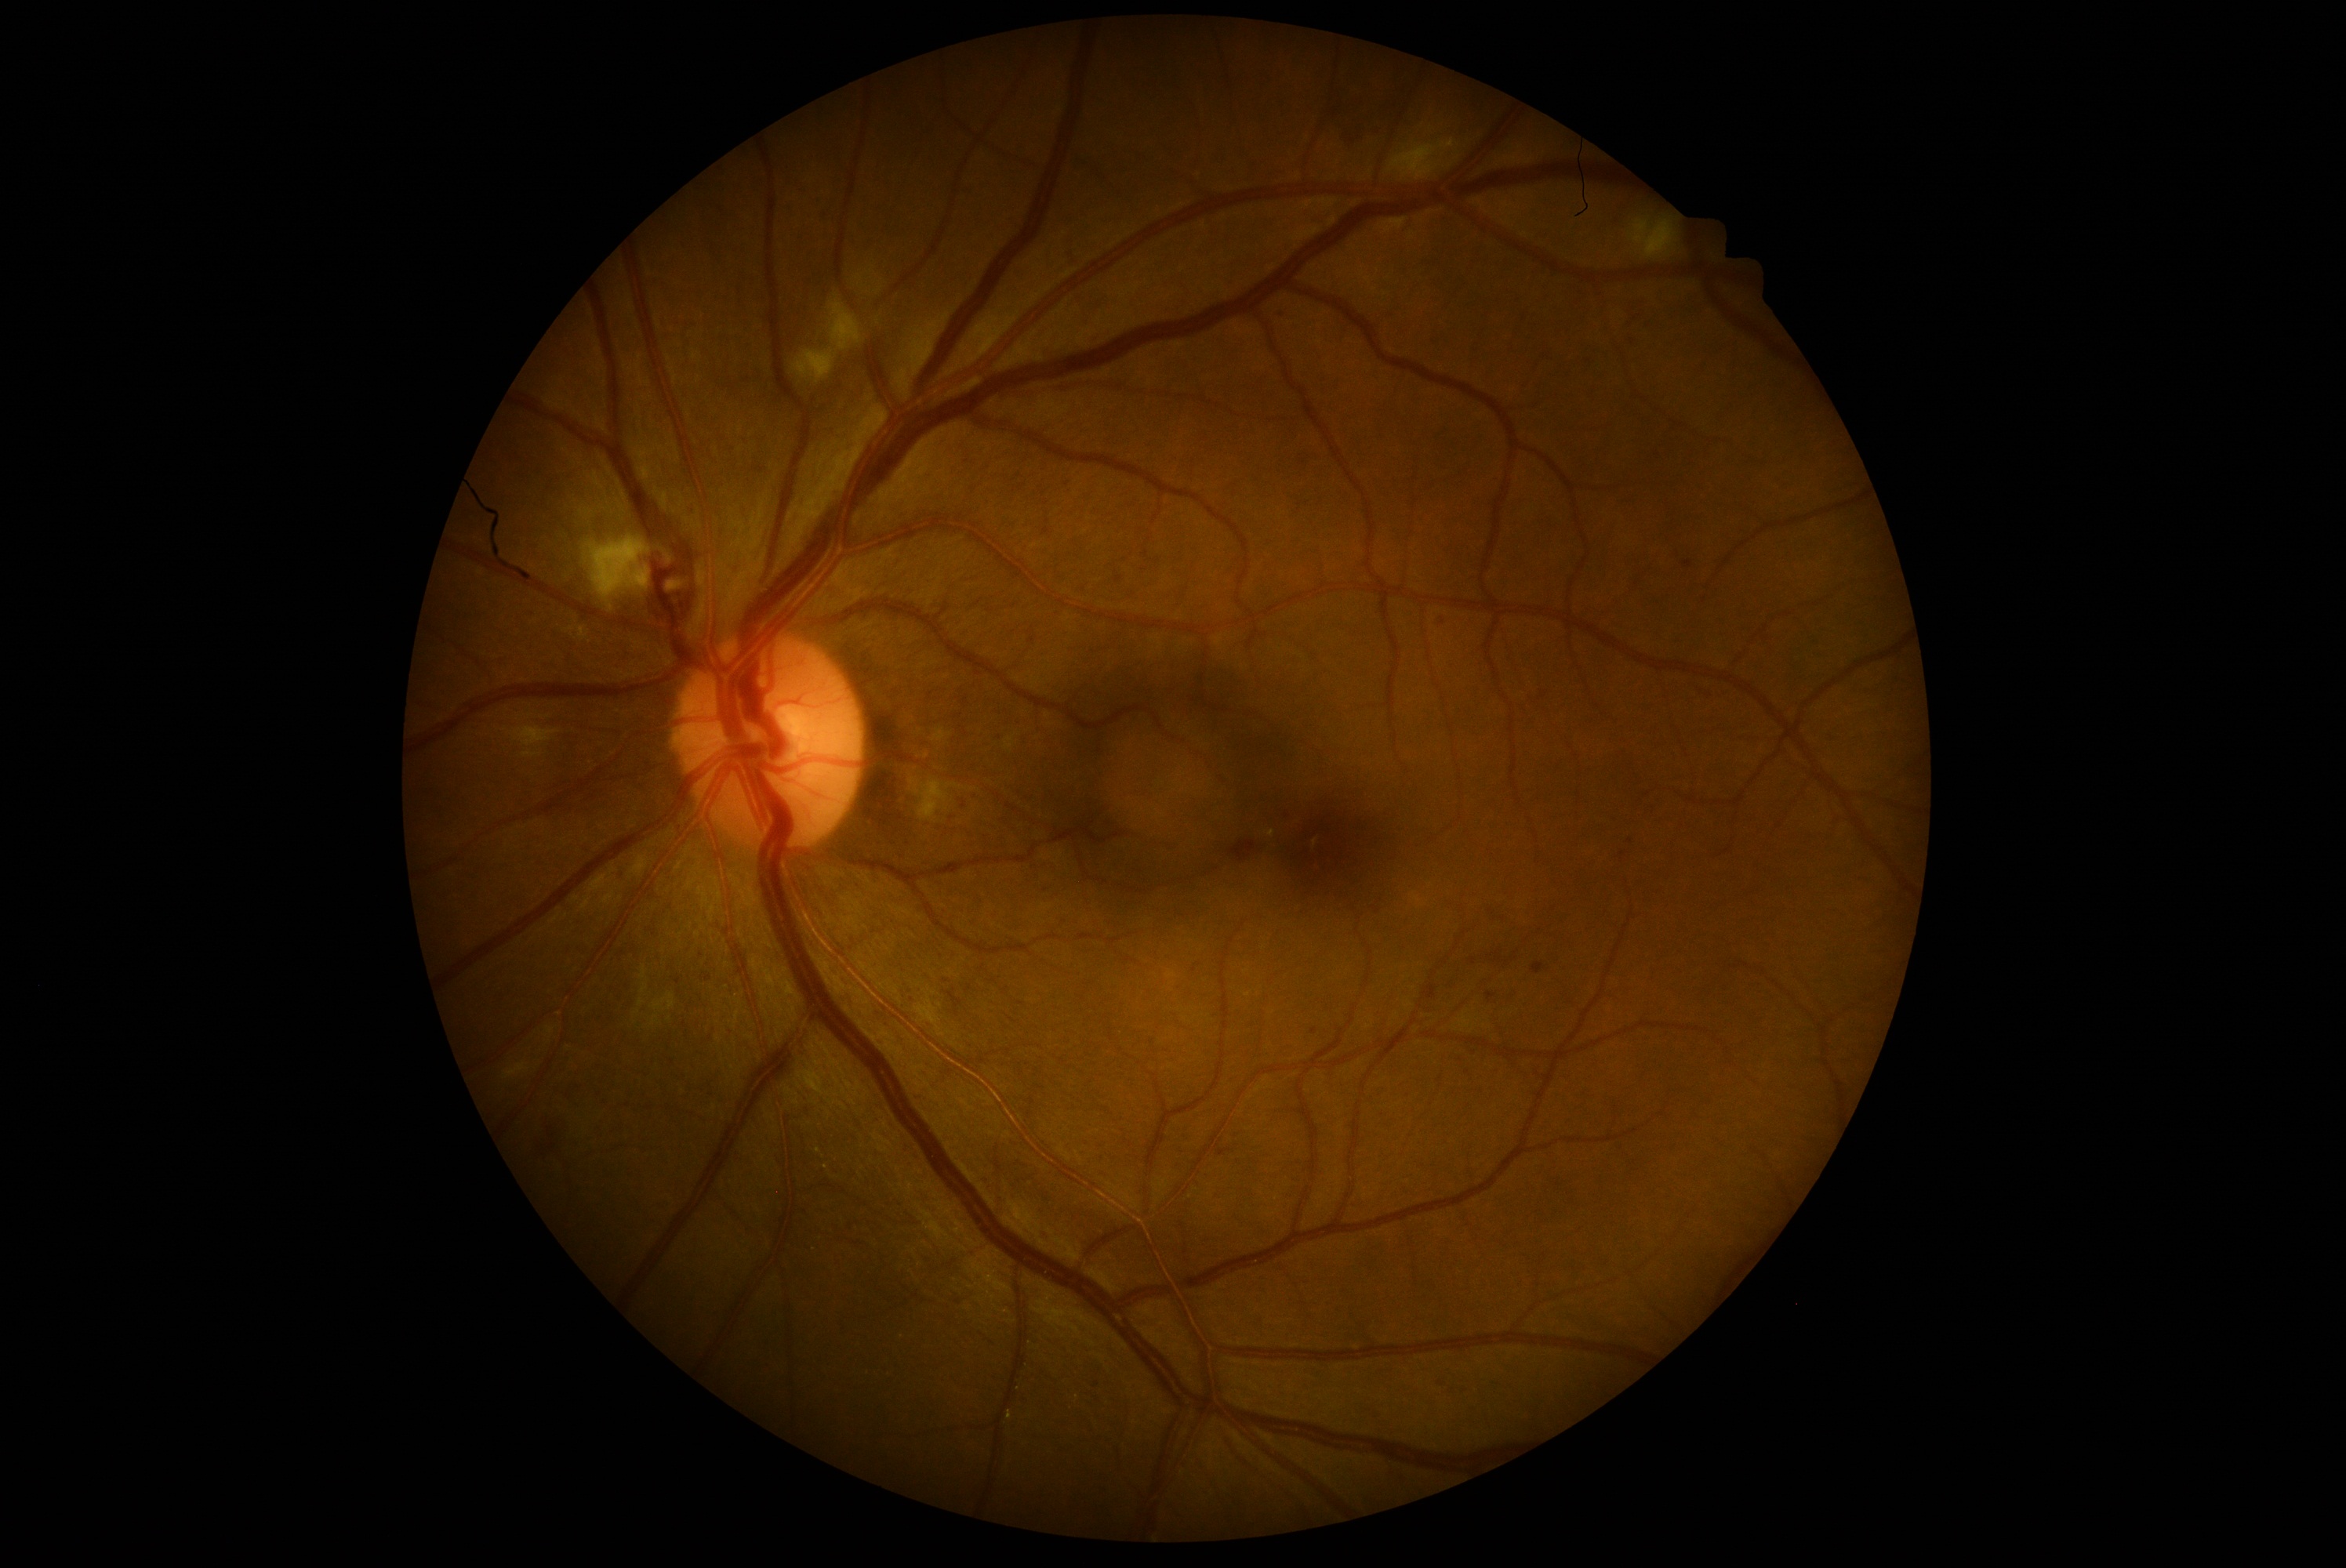

DR class: non-proliferative diabetic retinopathy.
DR grade: 2.